Posterior pole photograph; NIDEK AFC-230 fundus camera; modified Davis grading; without pupil dilation; FOV: 45 degrees — 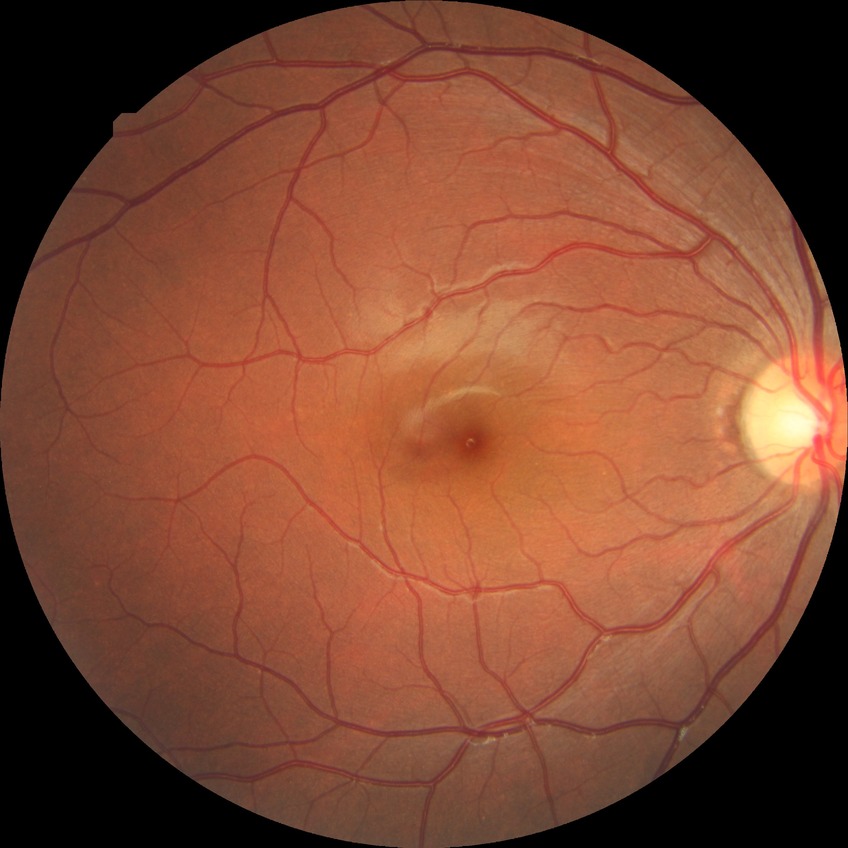

Retinopathy grade: no diabetic retinopathy.